Nidek AFC-330 · 240x240 · optic nerve head crop
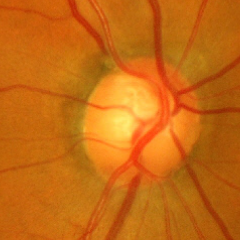 Glaucomatous changes are present. Glaucoma status: advanced-stage glaucoma. Defined as near-total cupping of the optic nerve head, with or without severe visual field loss within the central 10 degrees of fixation.